Retinal fundus photograph: 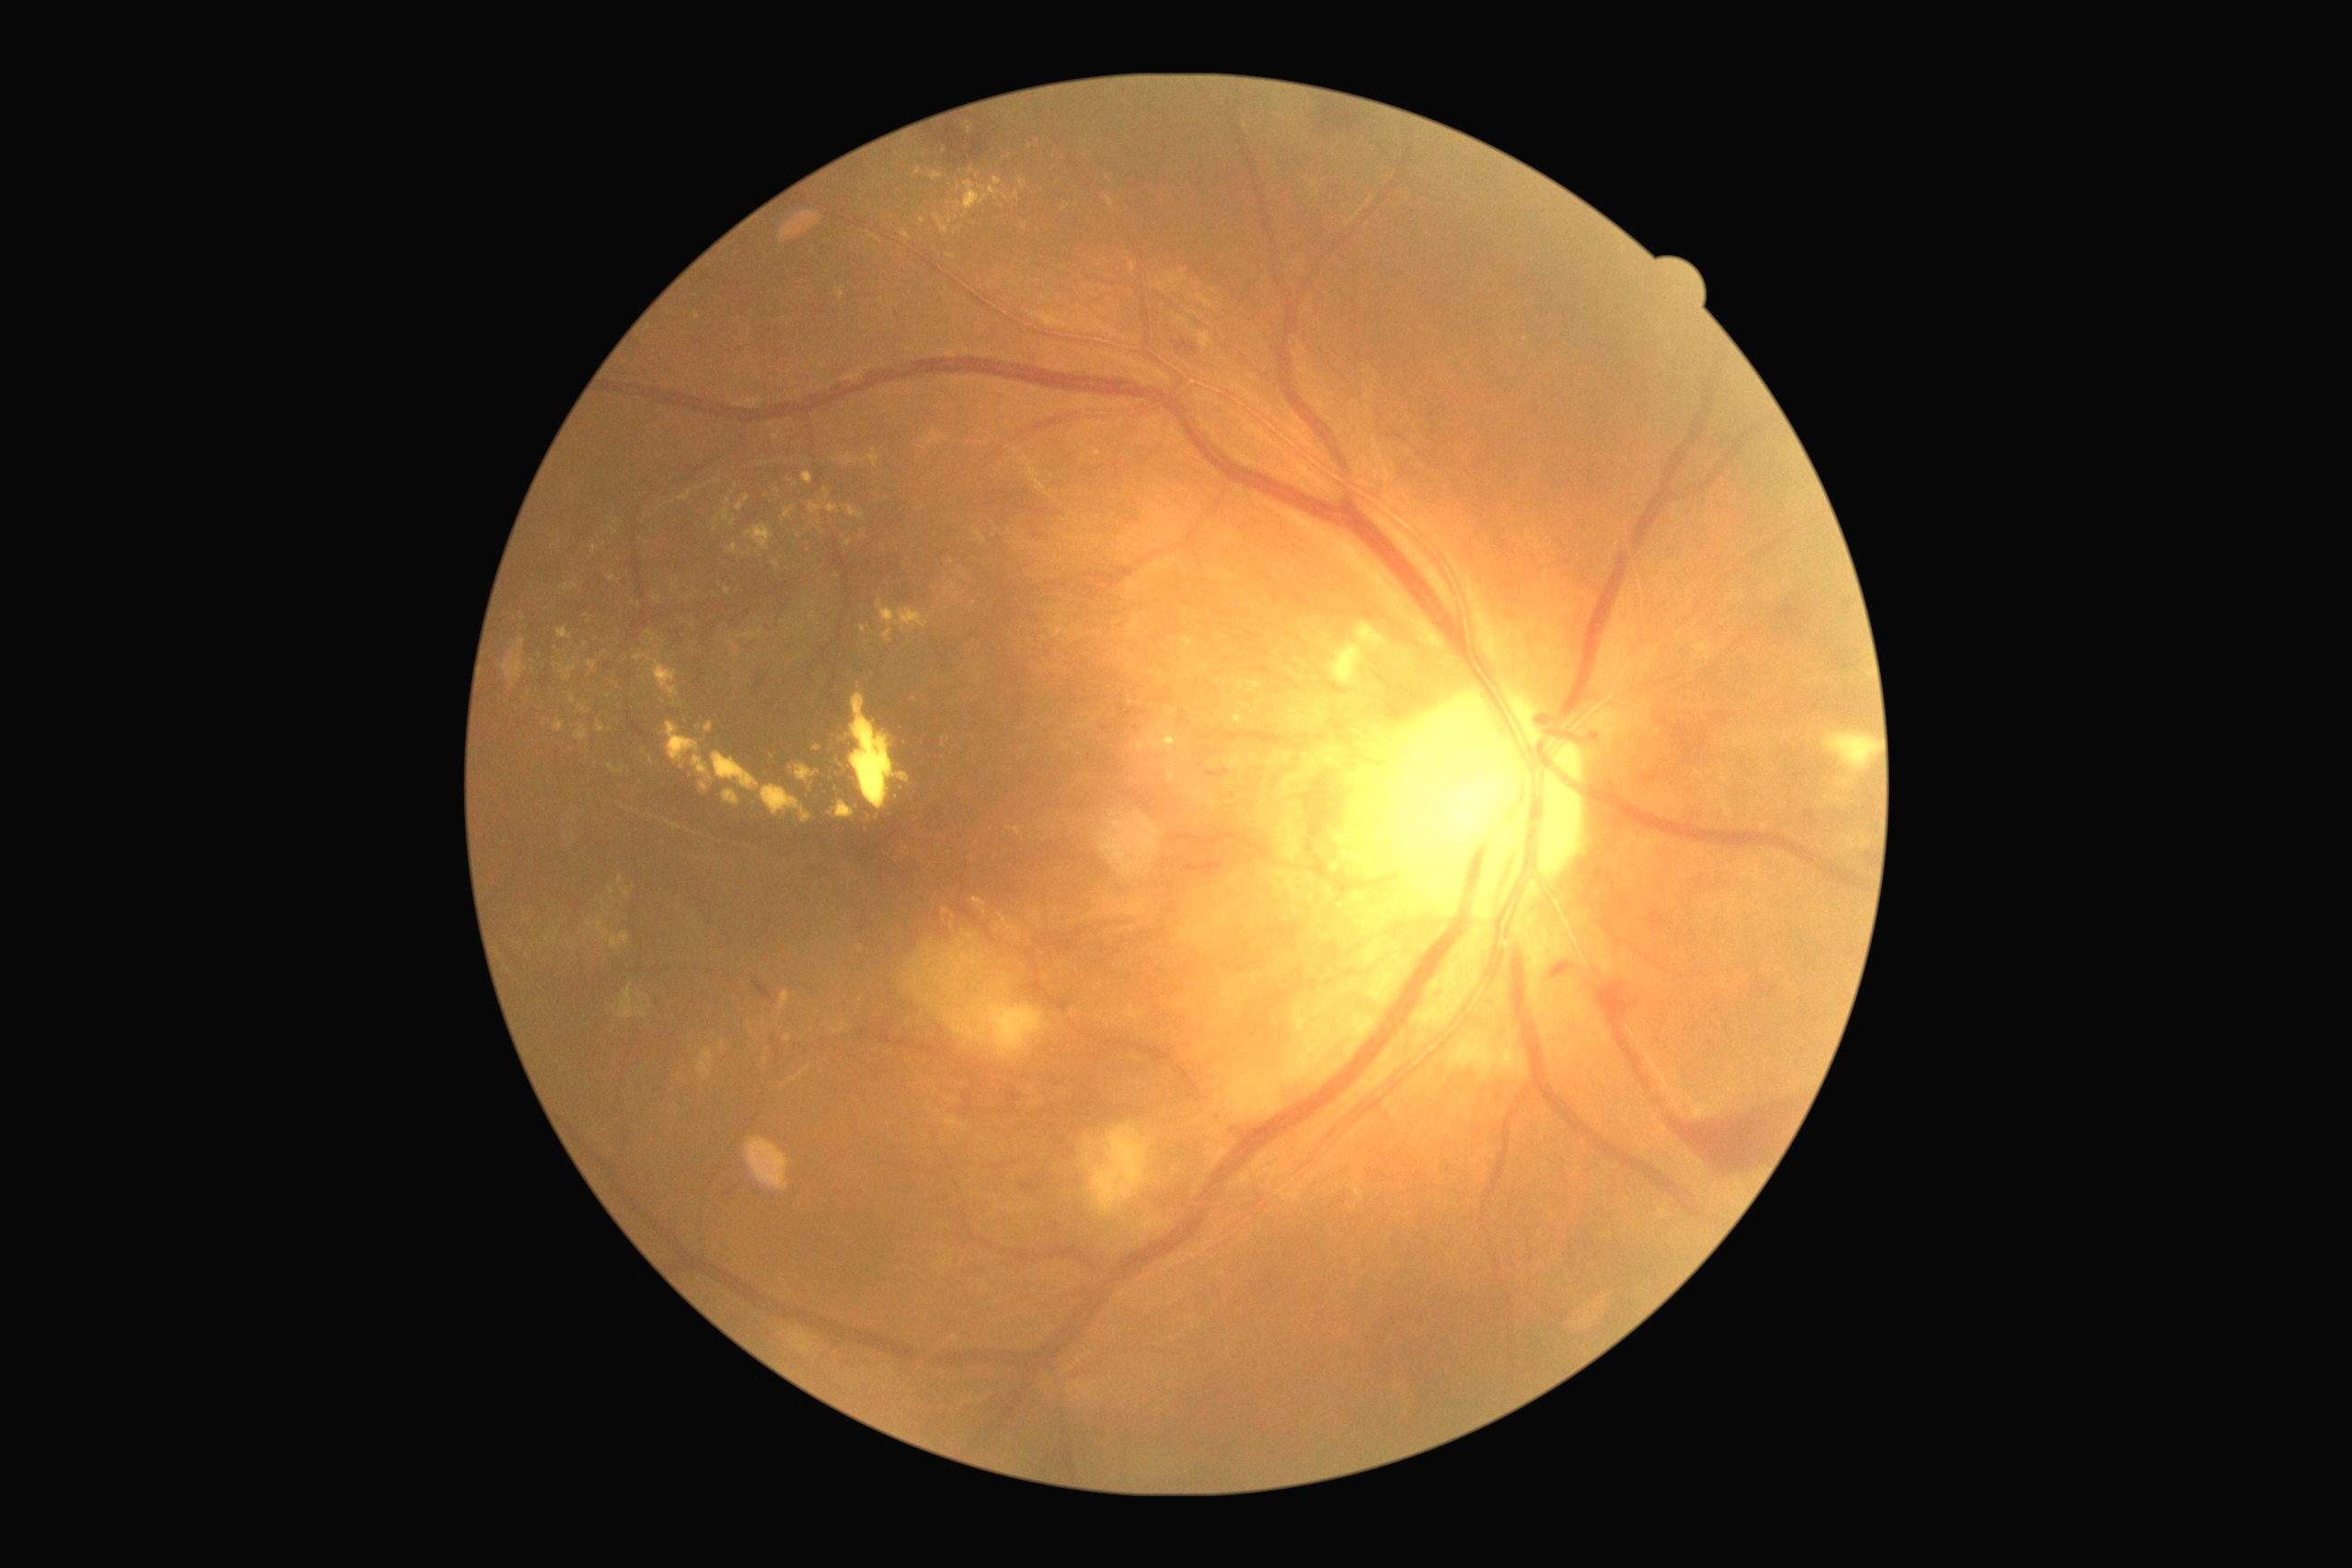 {"partial": true, "dr_grade": 4, "dr_grade_name": "PDR", "lesions": {"ex": [[1157, 282, 1166, 291], [623, 890, 631, 897], [901, 231, 912, 240], [779, 992, 790, 1010], [1001, 916, 1019, 937], [948, 255, 956, 259], [593, 545, 600, 554], [745, 525, 772, 551], [965, 122, 974, 135], [723, 790, 740, 807], [667, 723, 714, 792], [1331, 859, 1346, 872], [1335, 897, 1346, 912]], "ex_small_centers": [[1009, 828], [555, 939], [861, 999], [1245, 706], [620, 707], [717, 521]]}}